Modified Davis grading · 45-degree field of view · no pharmacologic dilation · 848 x 848 pixels · camera: NIDEK AFC-230 · posterior pole photograph: 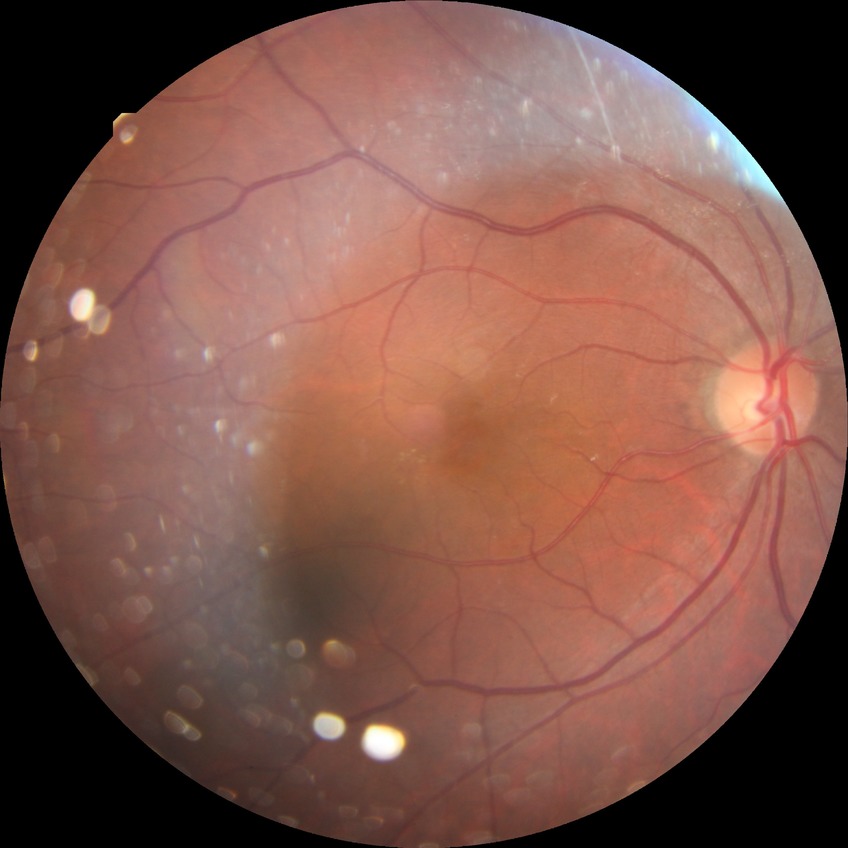

DR severity is SDR.